45° FOV.
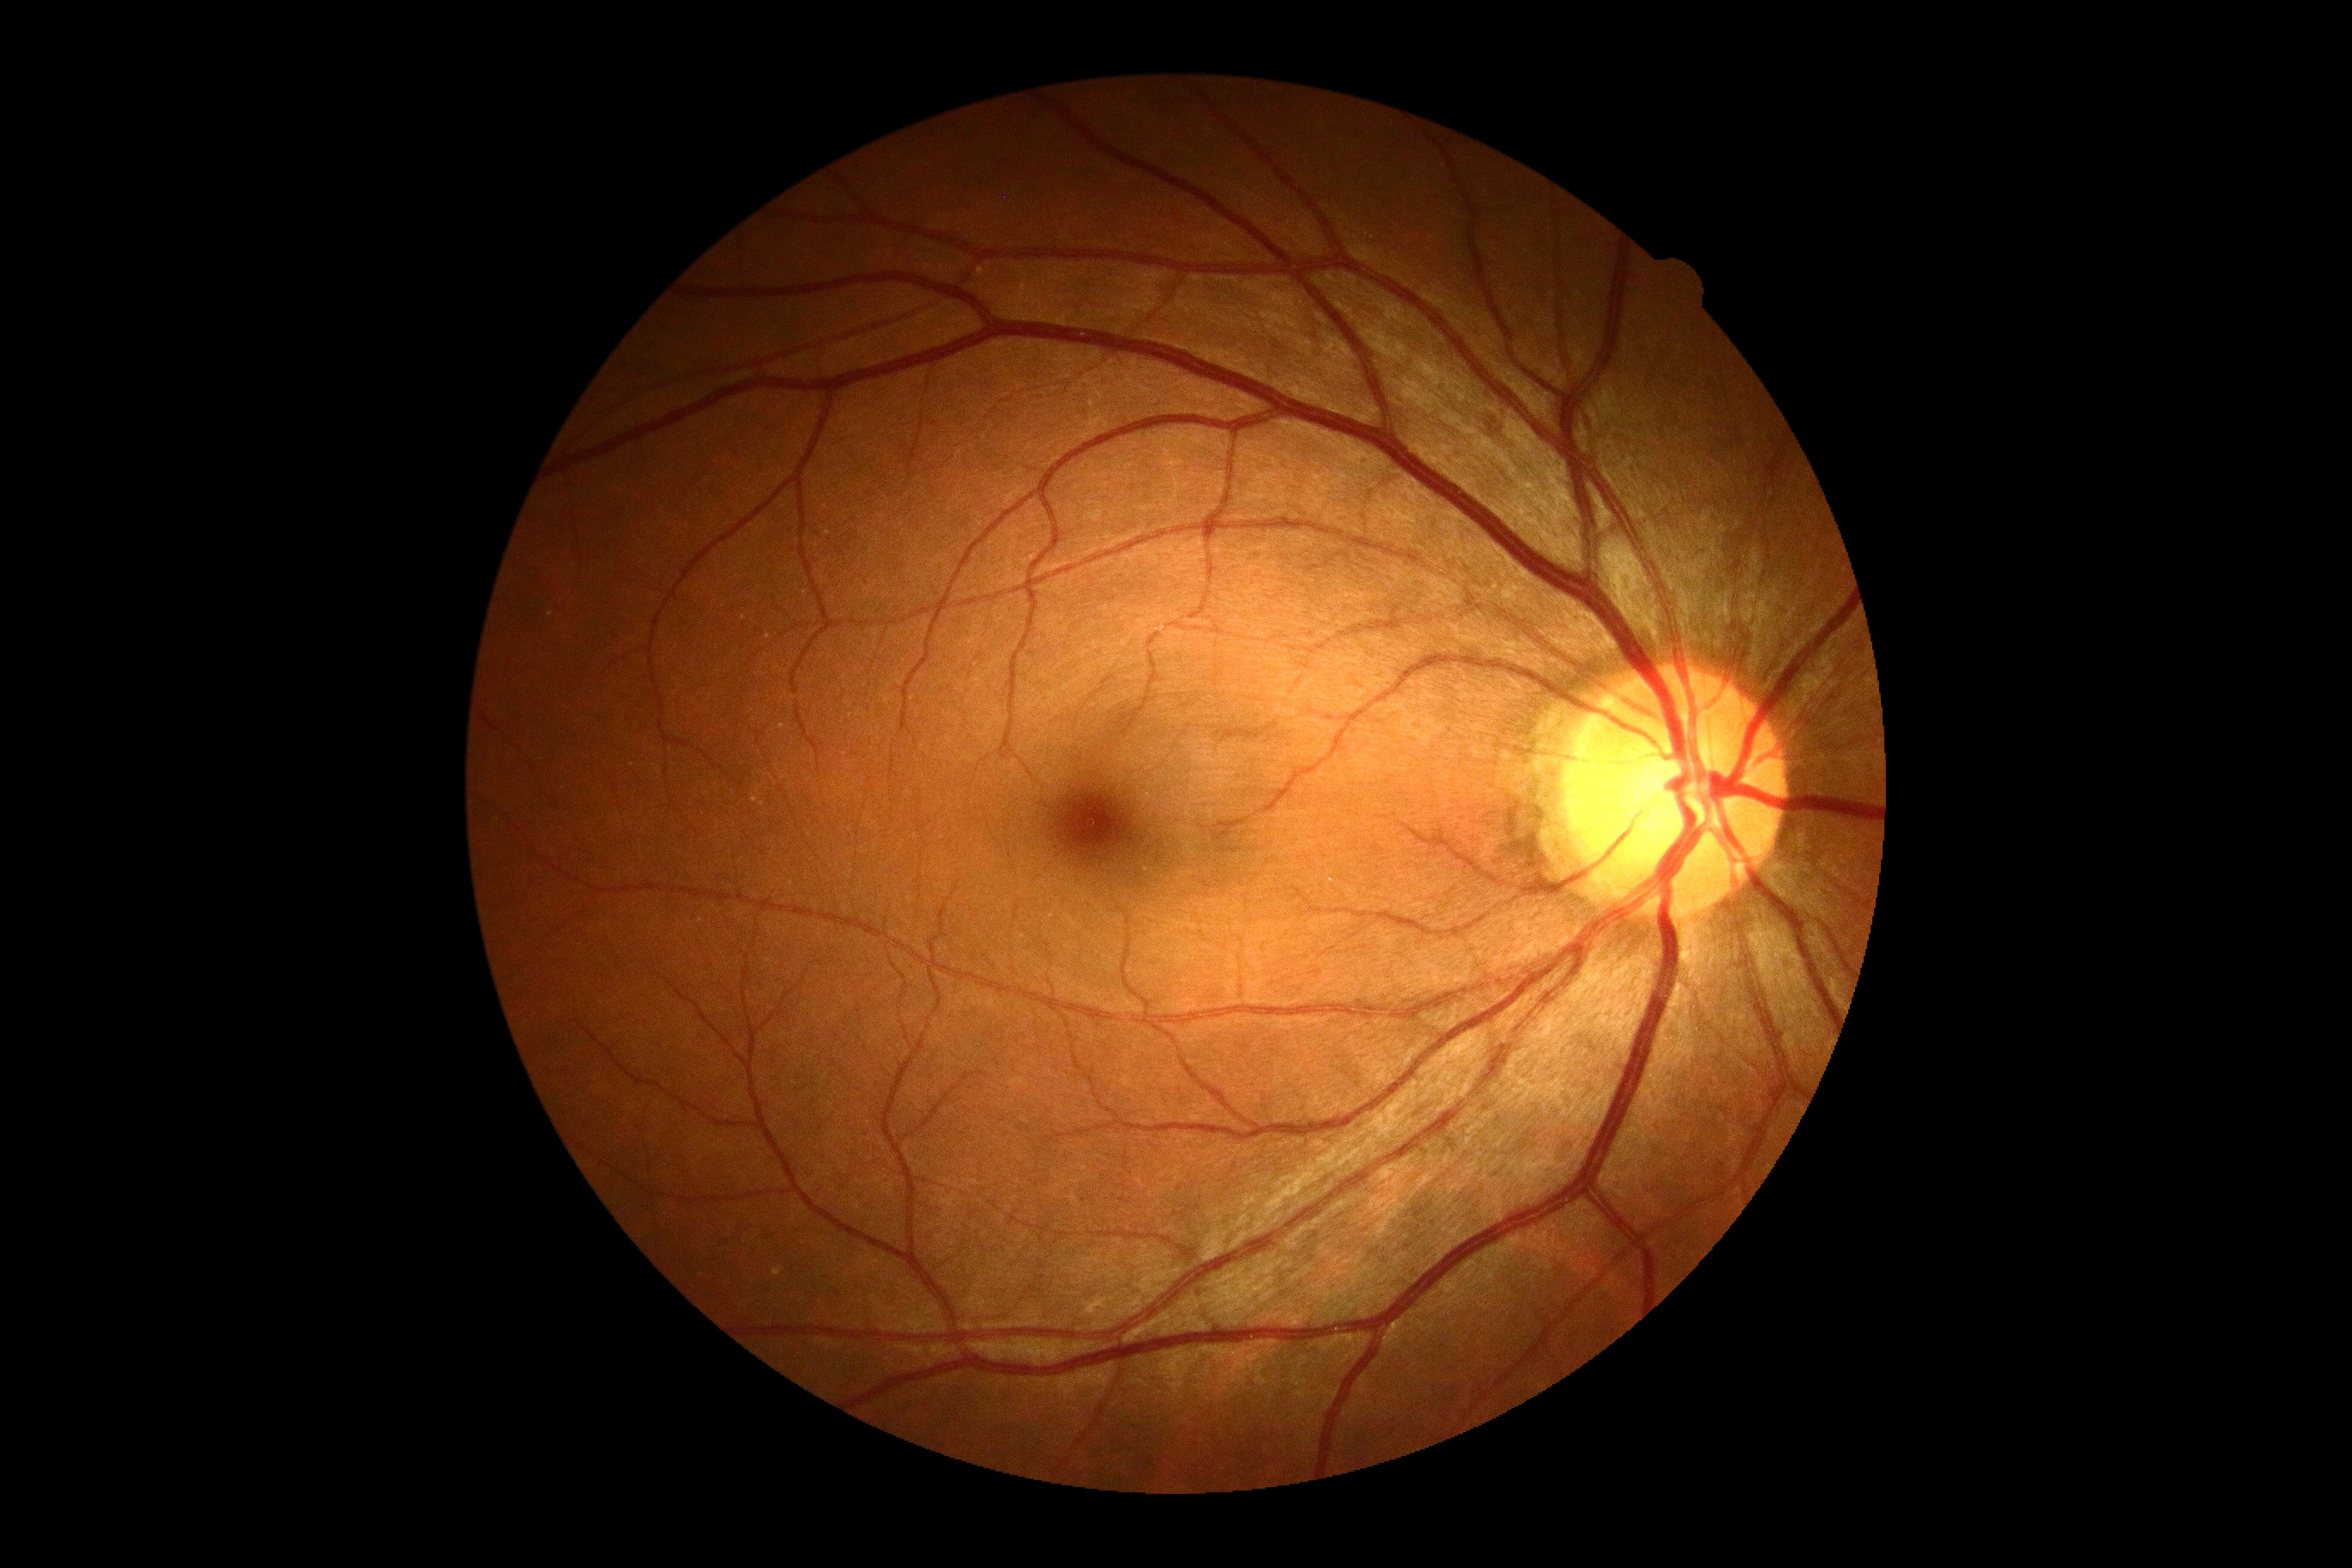

Retinopathy grade: 0 — no visible signs of diabetic retinopathy.